Infant wide-field retinal image.
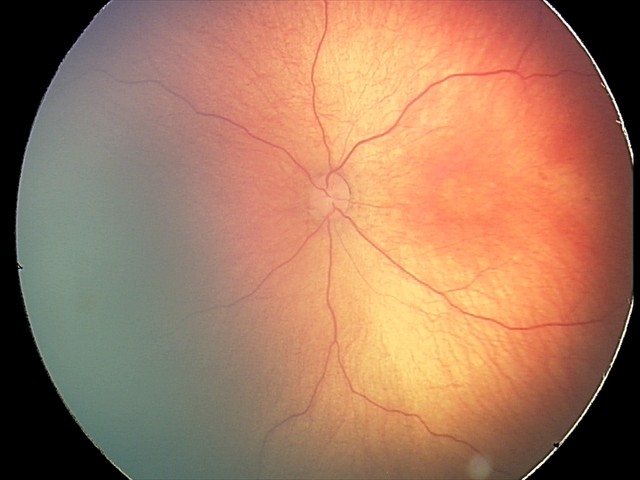

Screening diagnosis: retinal hemorrhages.